DR severity per modified Davis staging. CFP
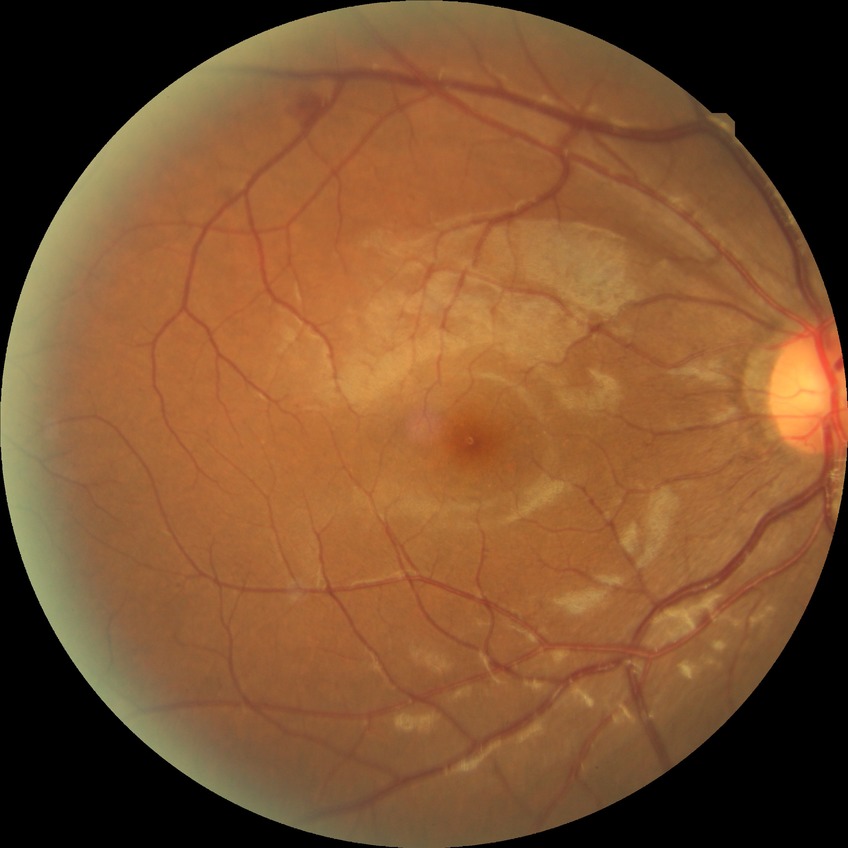

Modified Davis grading is simple diabetic retinopathy.